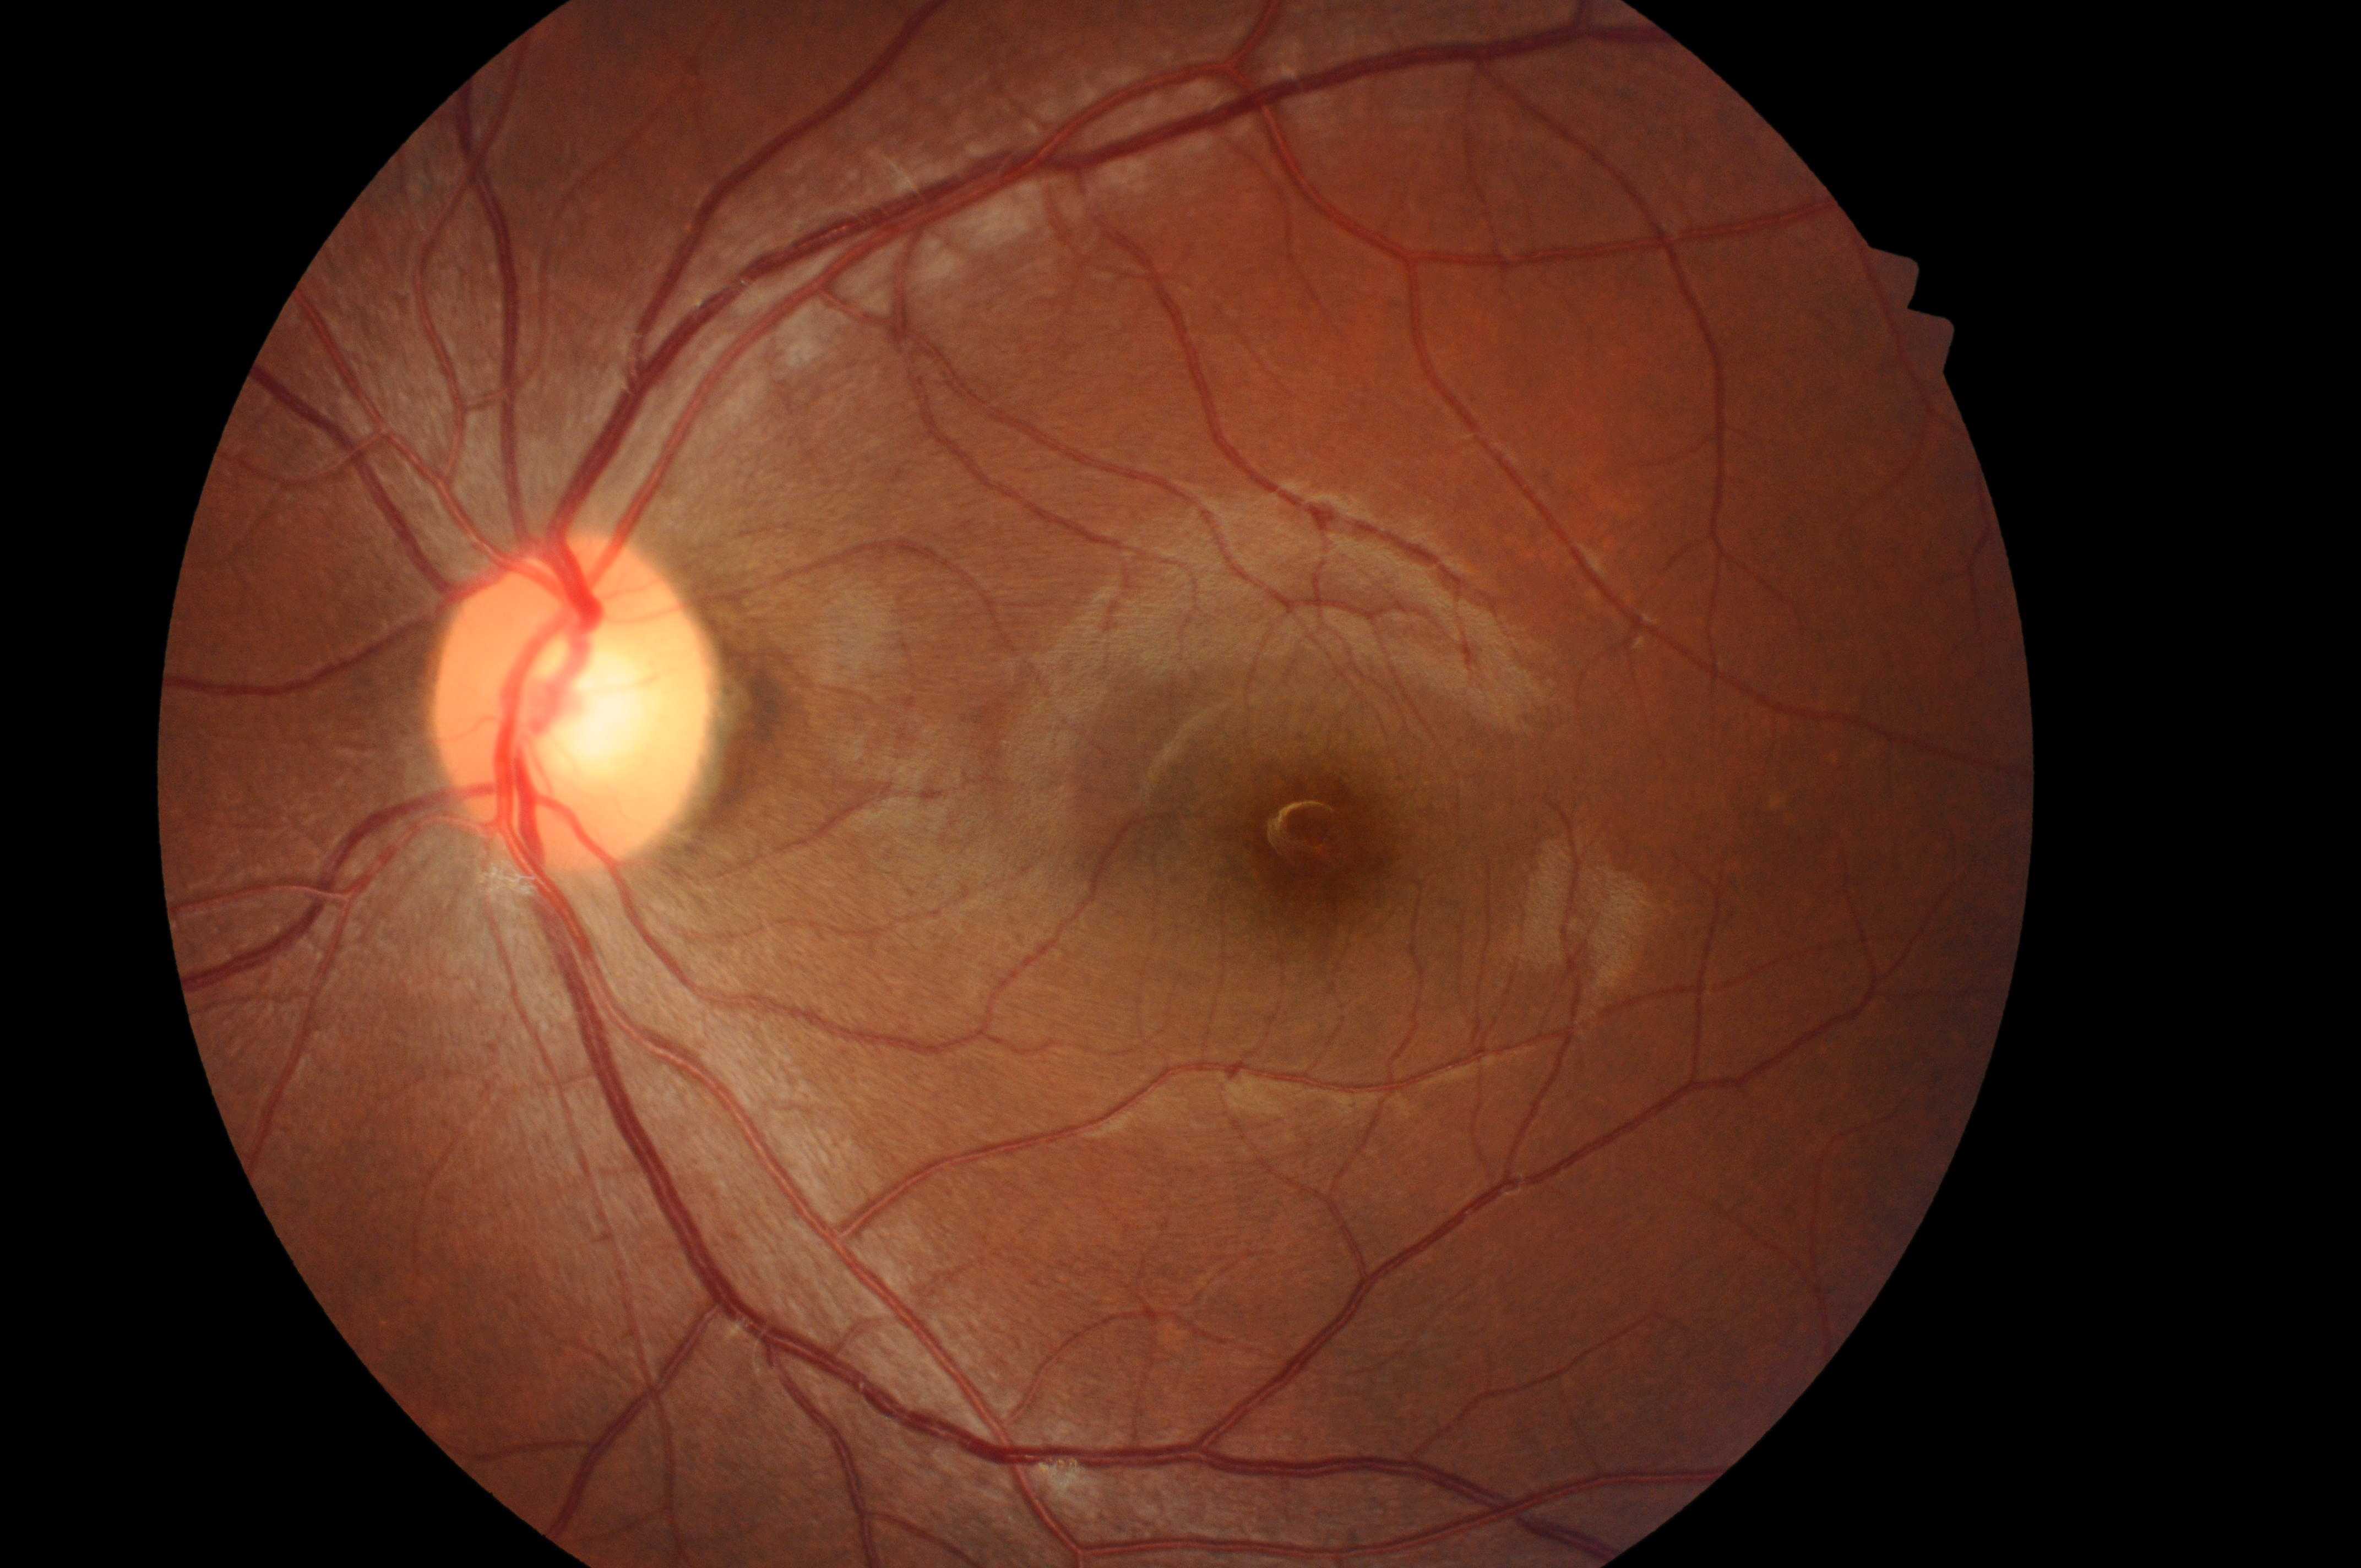

ONH located at 565px, 715px.
No apparent diabetic retinopathy or macular edema.
DME: 0.
DR is 0.
This is the left eye.
Fovea centralis: 1320px, 847px.